45° field of view.
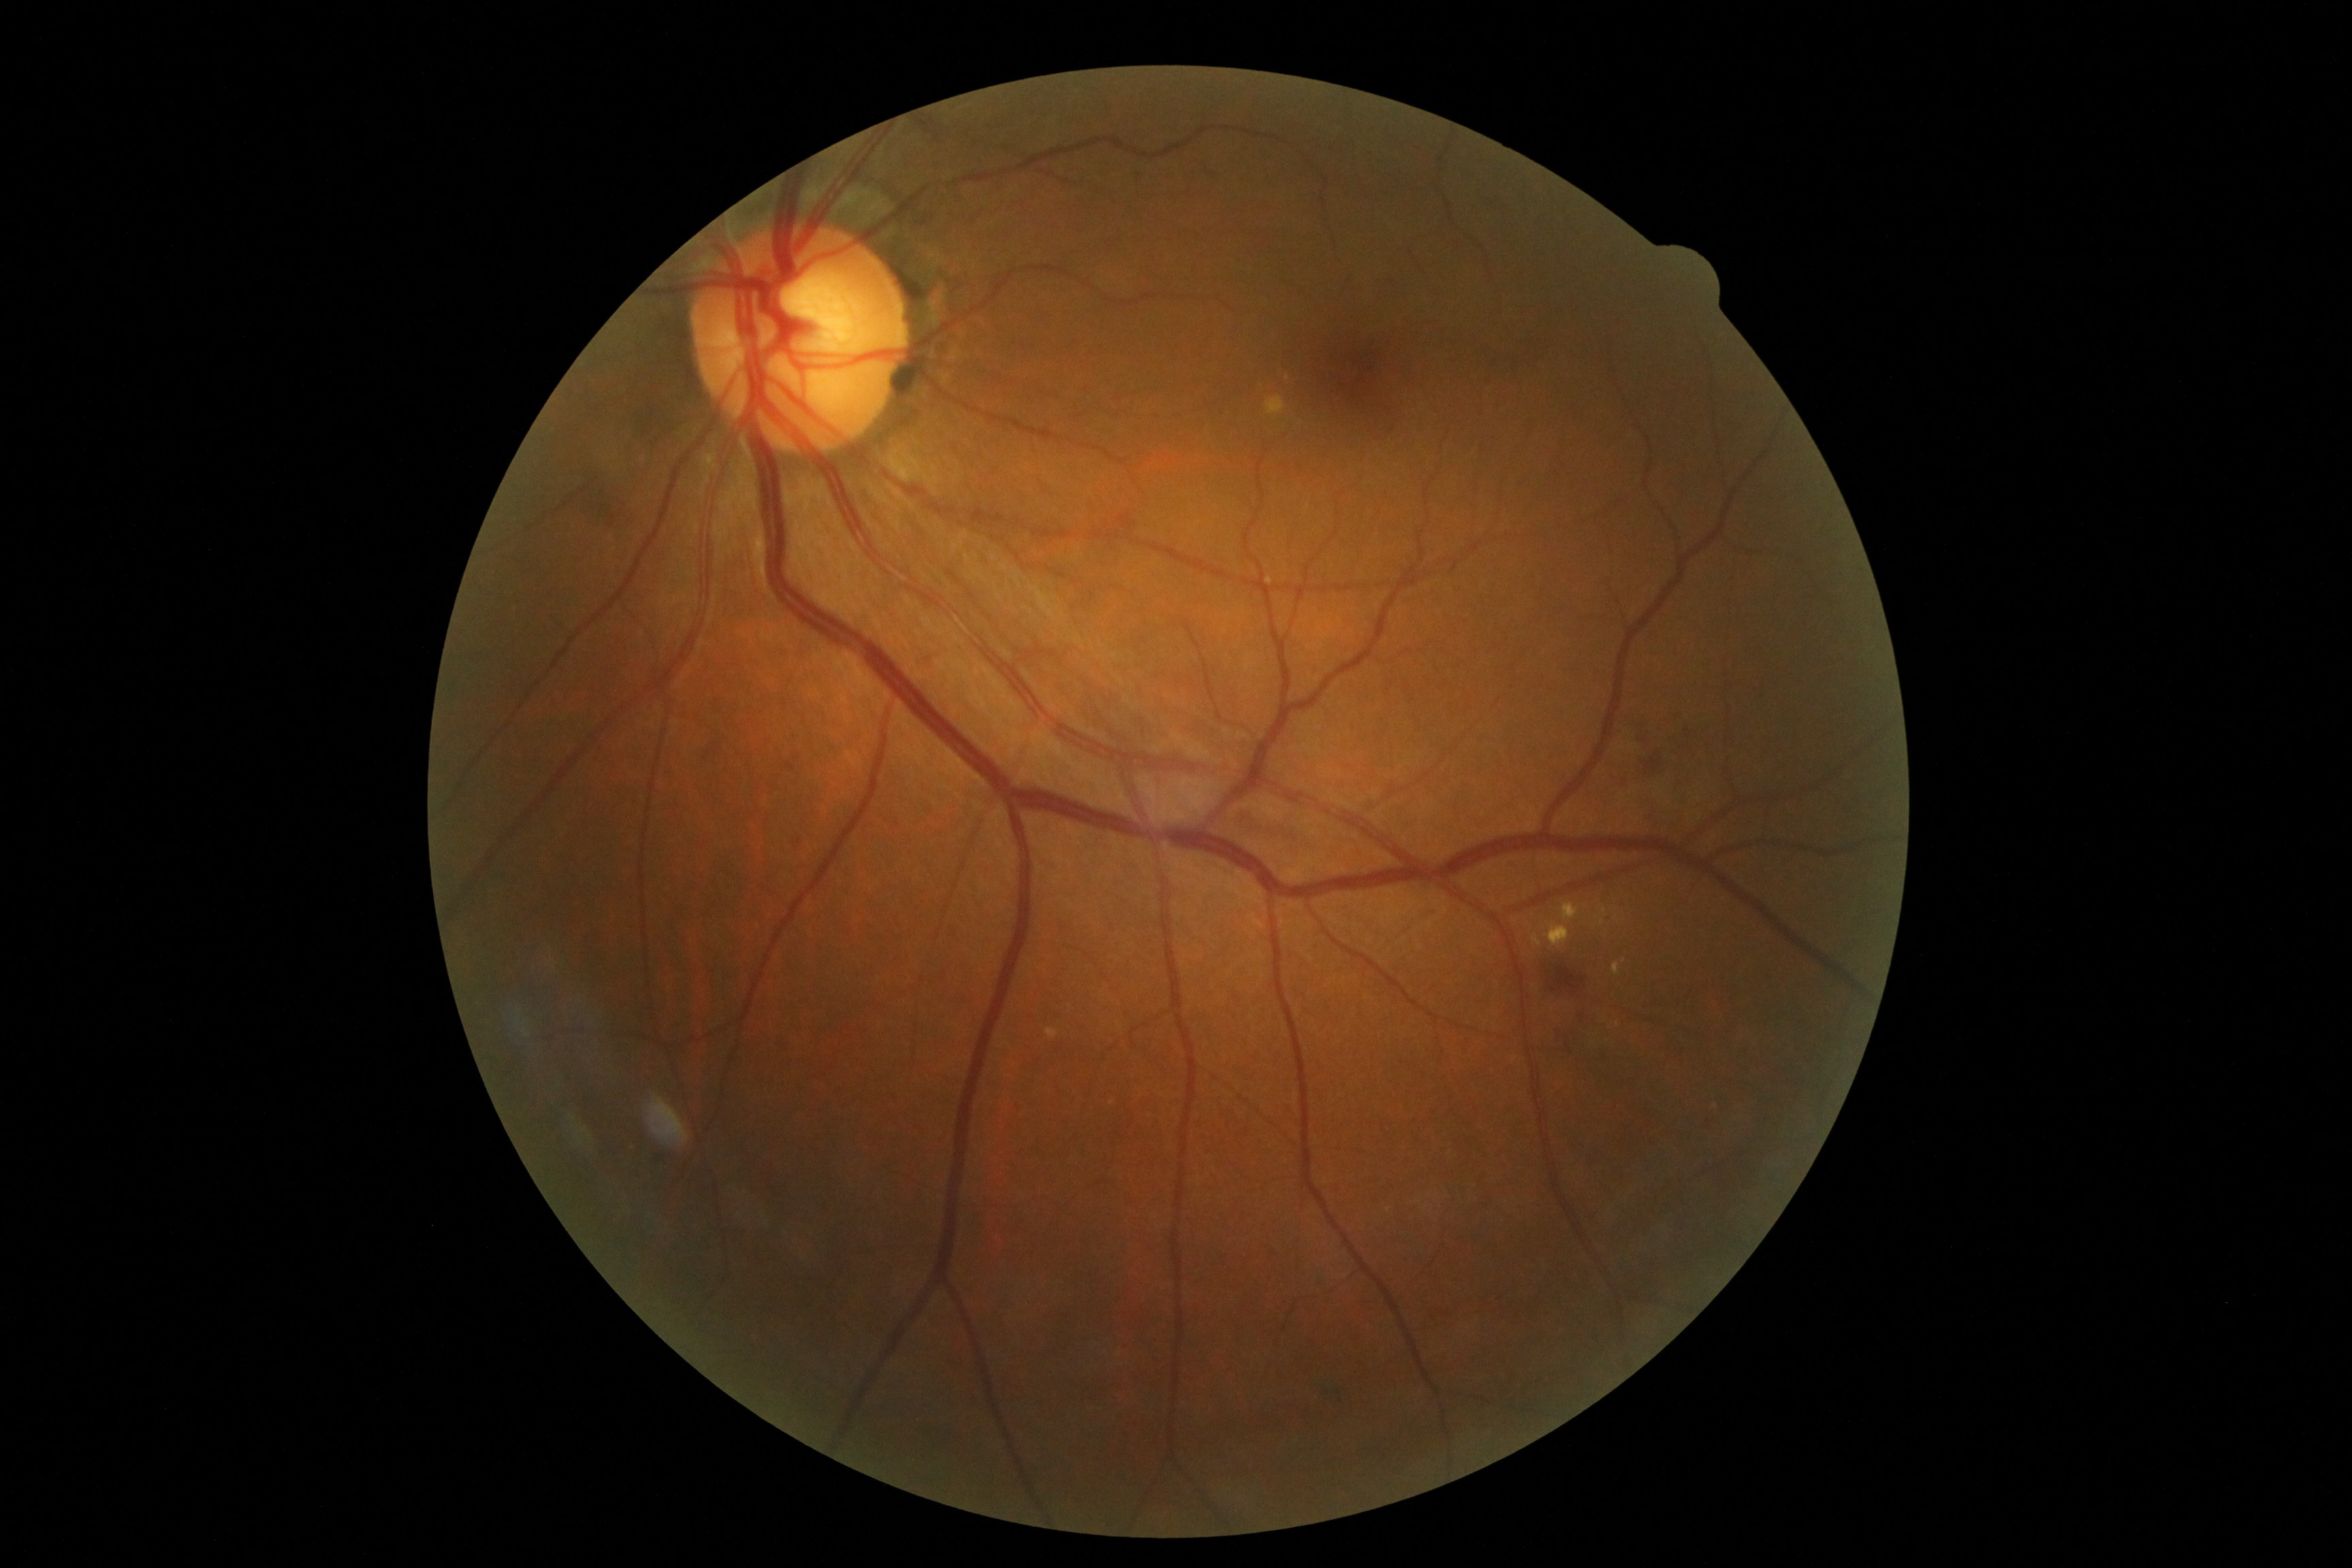
Diabetic retinopathy (DR) is moderate NPDR (grade 2); non-proliferative diabetic retinopathy. No soft exudates (SEs) identified. Hard exudates (EXs) are located at [x1=1544, y1=922, x2=1570, y2=948]; [x1=1562, y1=903, x2=1580, y2=924]; [x1=1532, y1=933, x2=1543, y2=947]; [x1=1614, y1=963, x2=1620, y2=975]. Small EXs near x=1624, y=961. Hemorrhages (HEs) are located at [x1=786, y1=764, x2=796, y2=771]; [x1=1132, y1=171, x2=1141, y2=178]; [x1=1537, y1=948, x2=1585, y2=997]; [x1=585, y1=488, x2=631, y2=537]; [x1=1207, y1=169, x2=1219, y2=179]; [x1=1644, y1=753, x2=1663, y2=775]. Small HEs near x=1641, y=740; x=799, y=842. No microaneurysms (MAs) identified.